Fundus photo
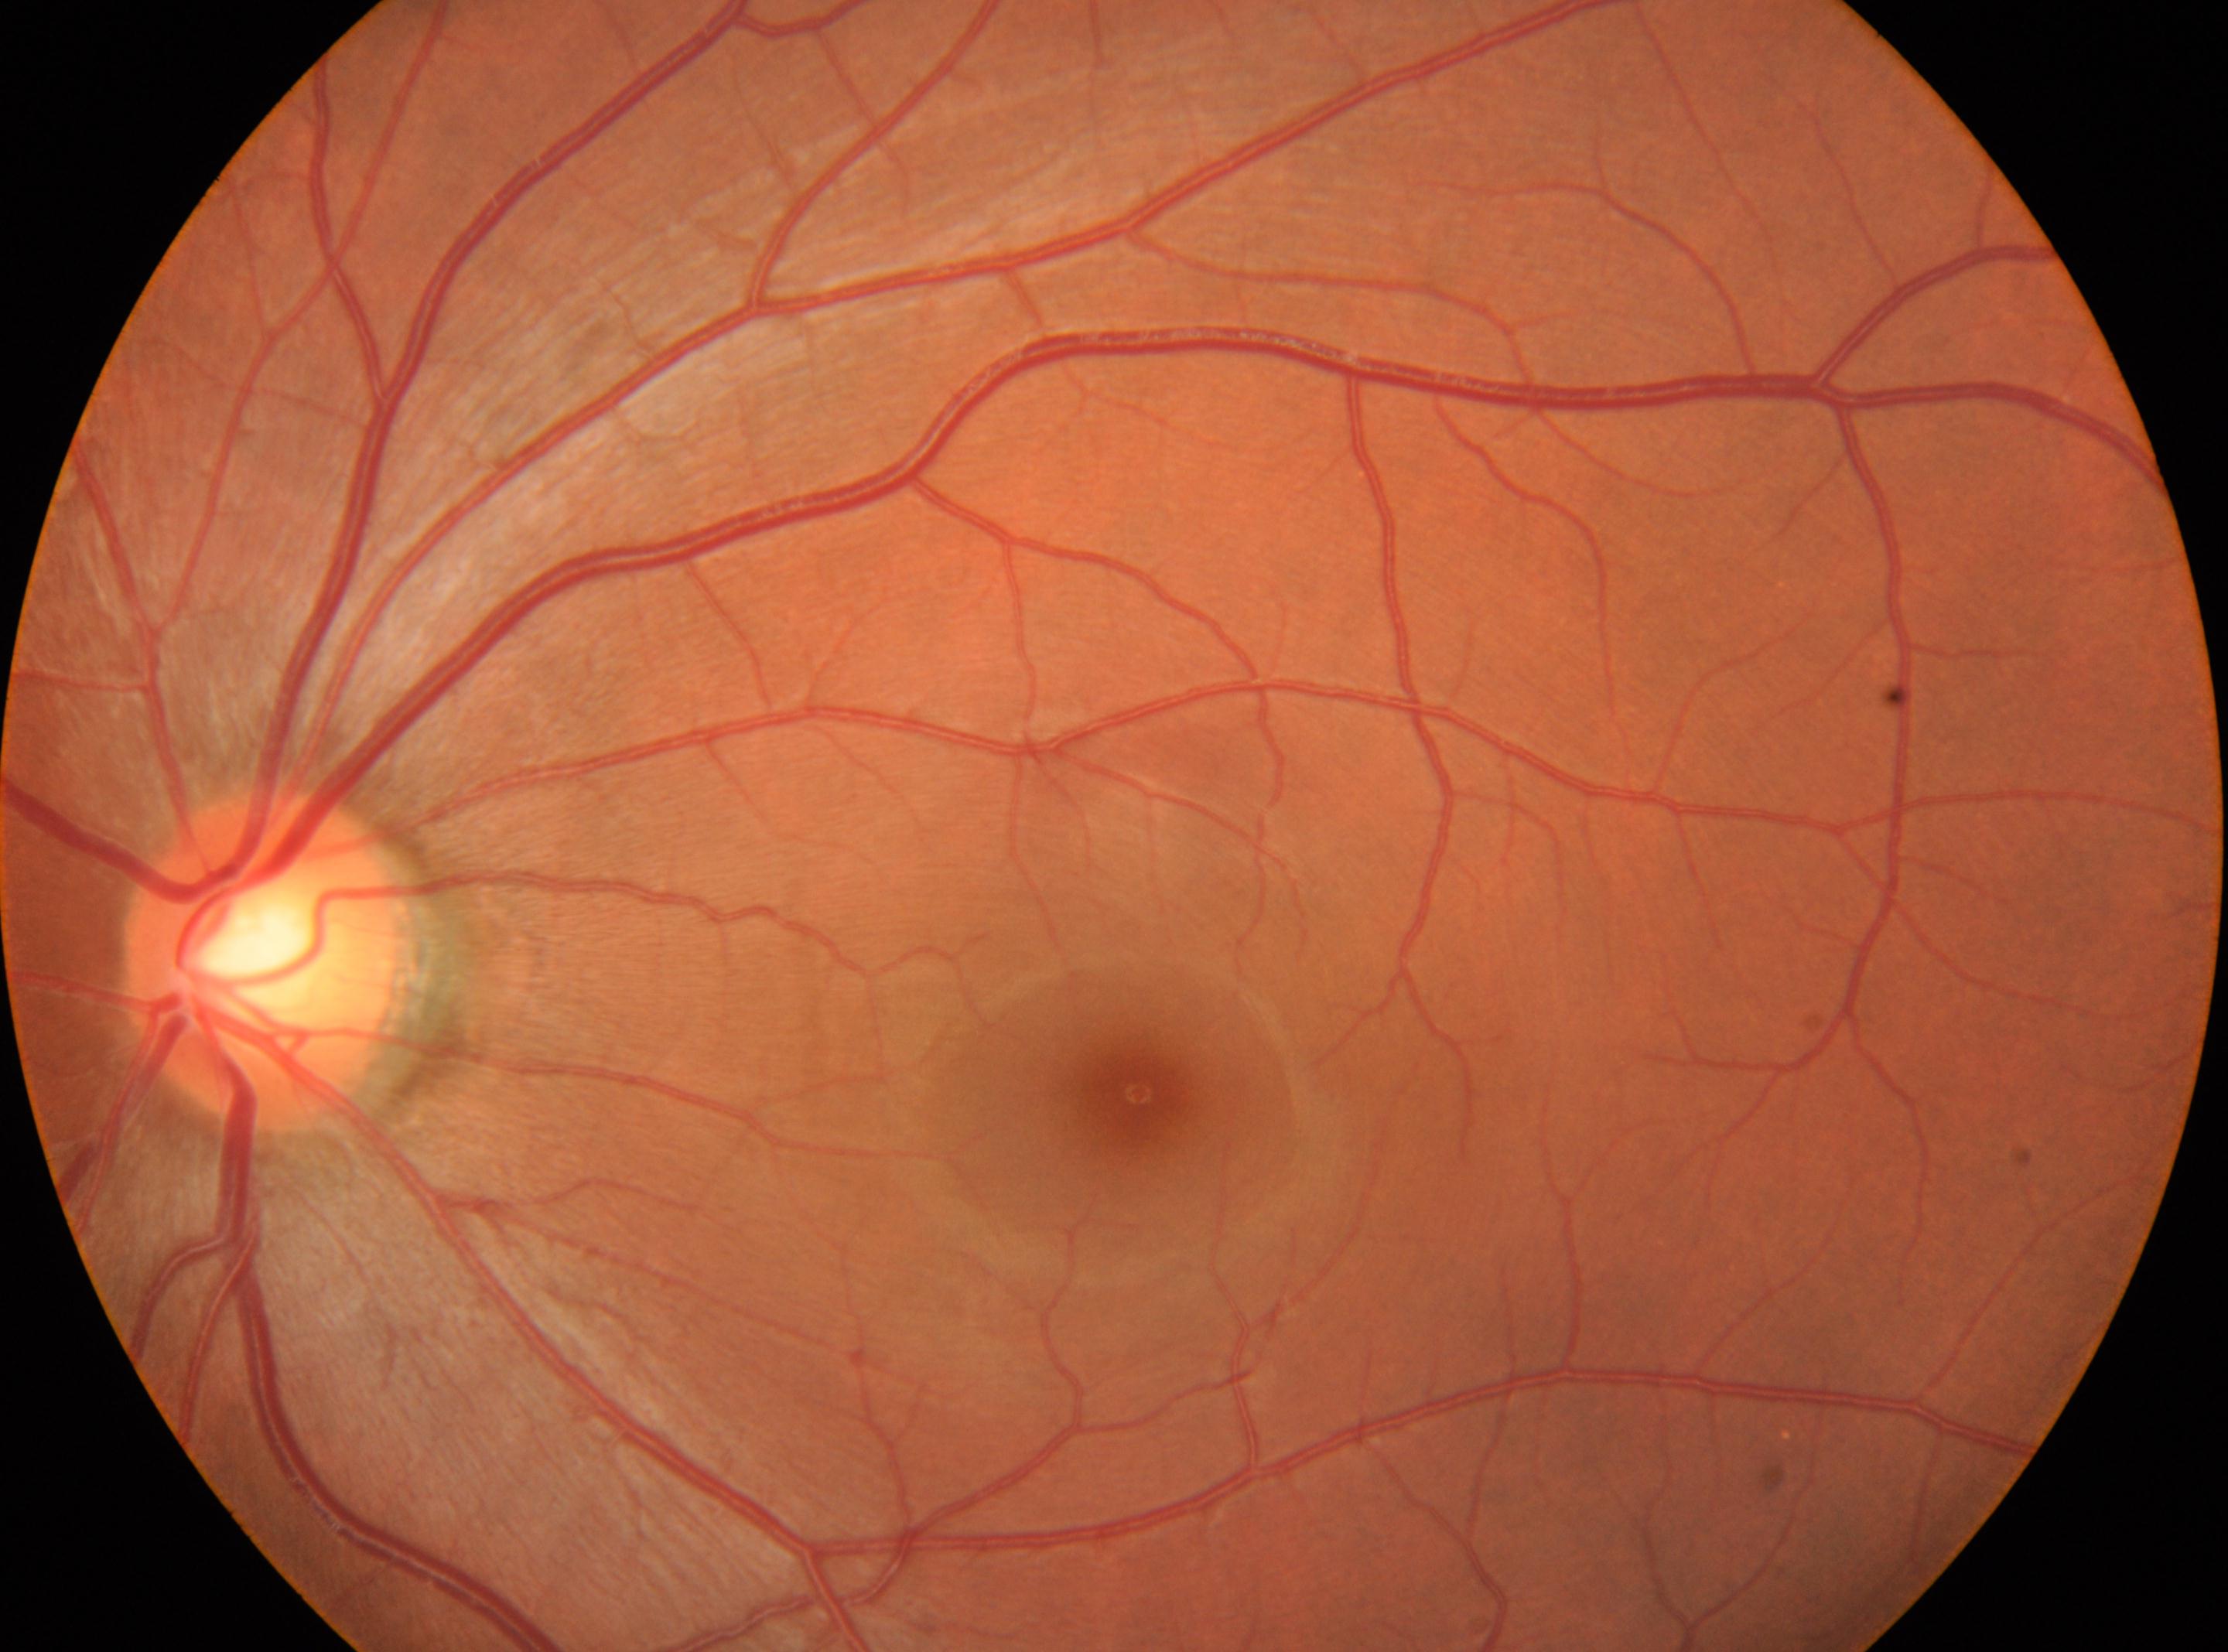

disc center@266px, 956px
fovea centralis@1139px, 1092px
DR grade@0
No diabetic retinal disease findings
left